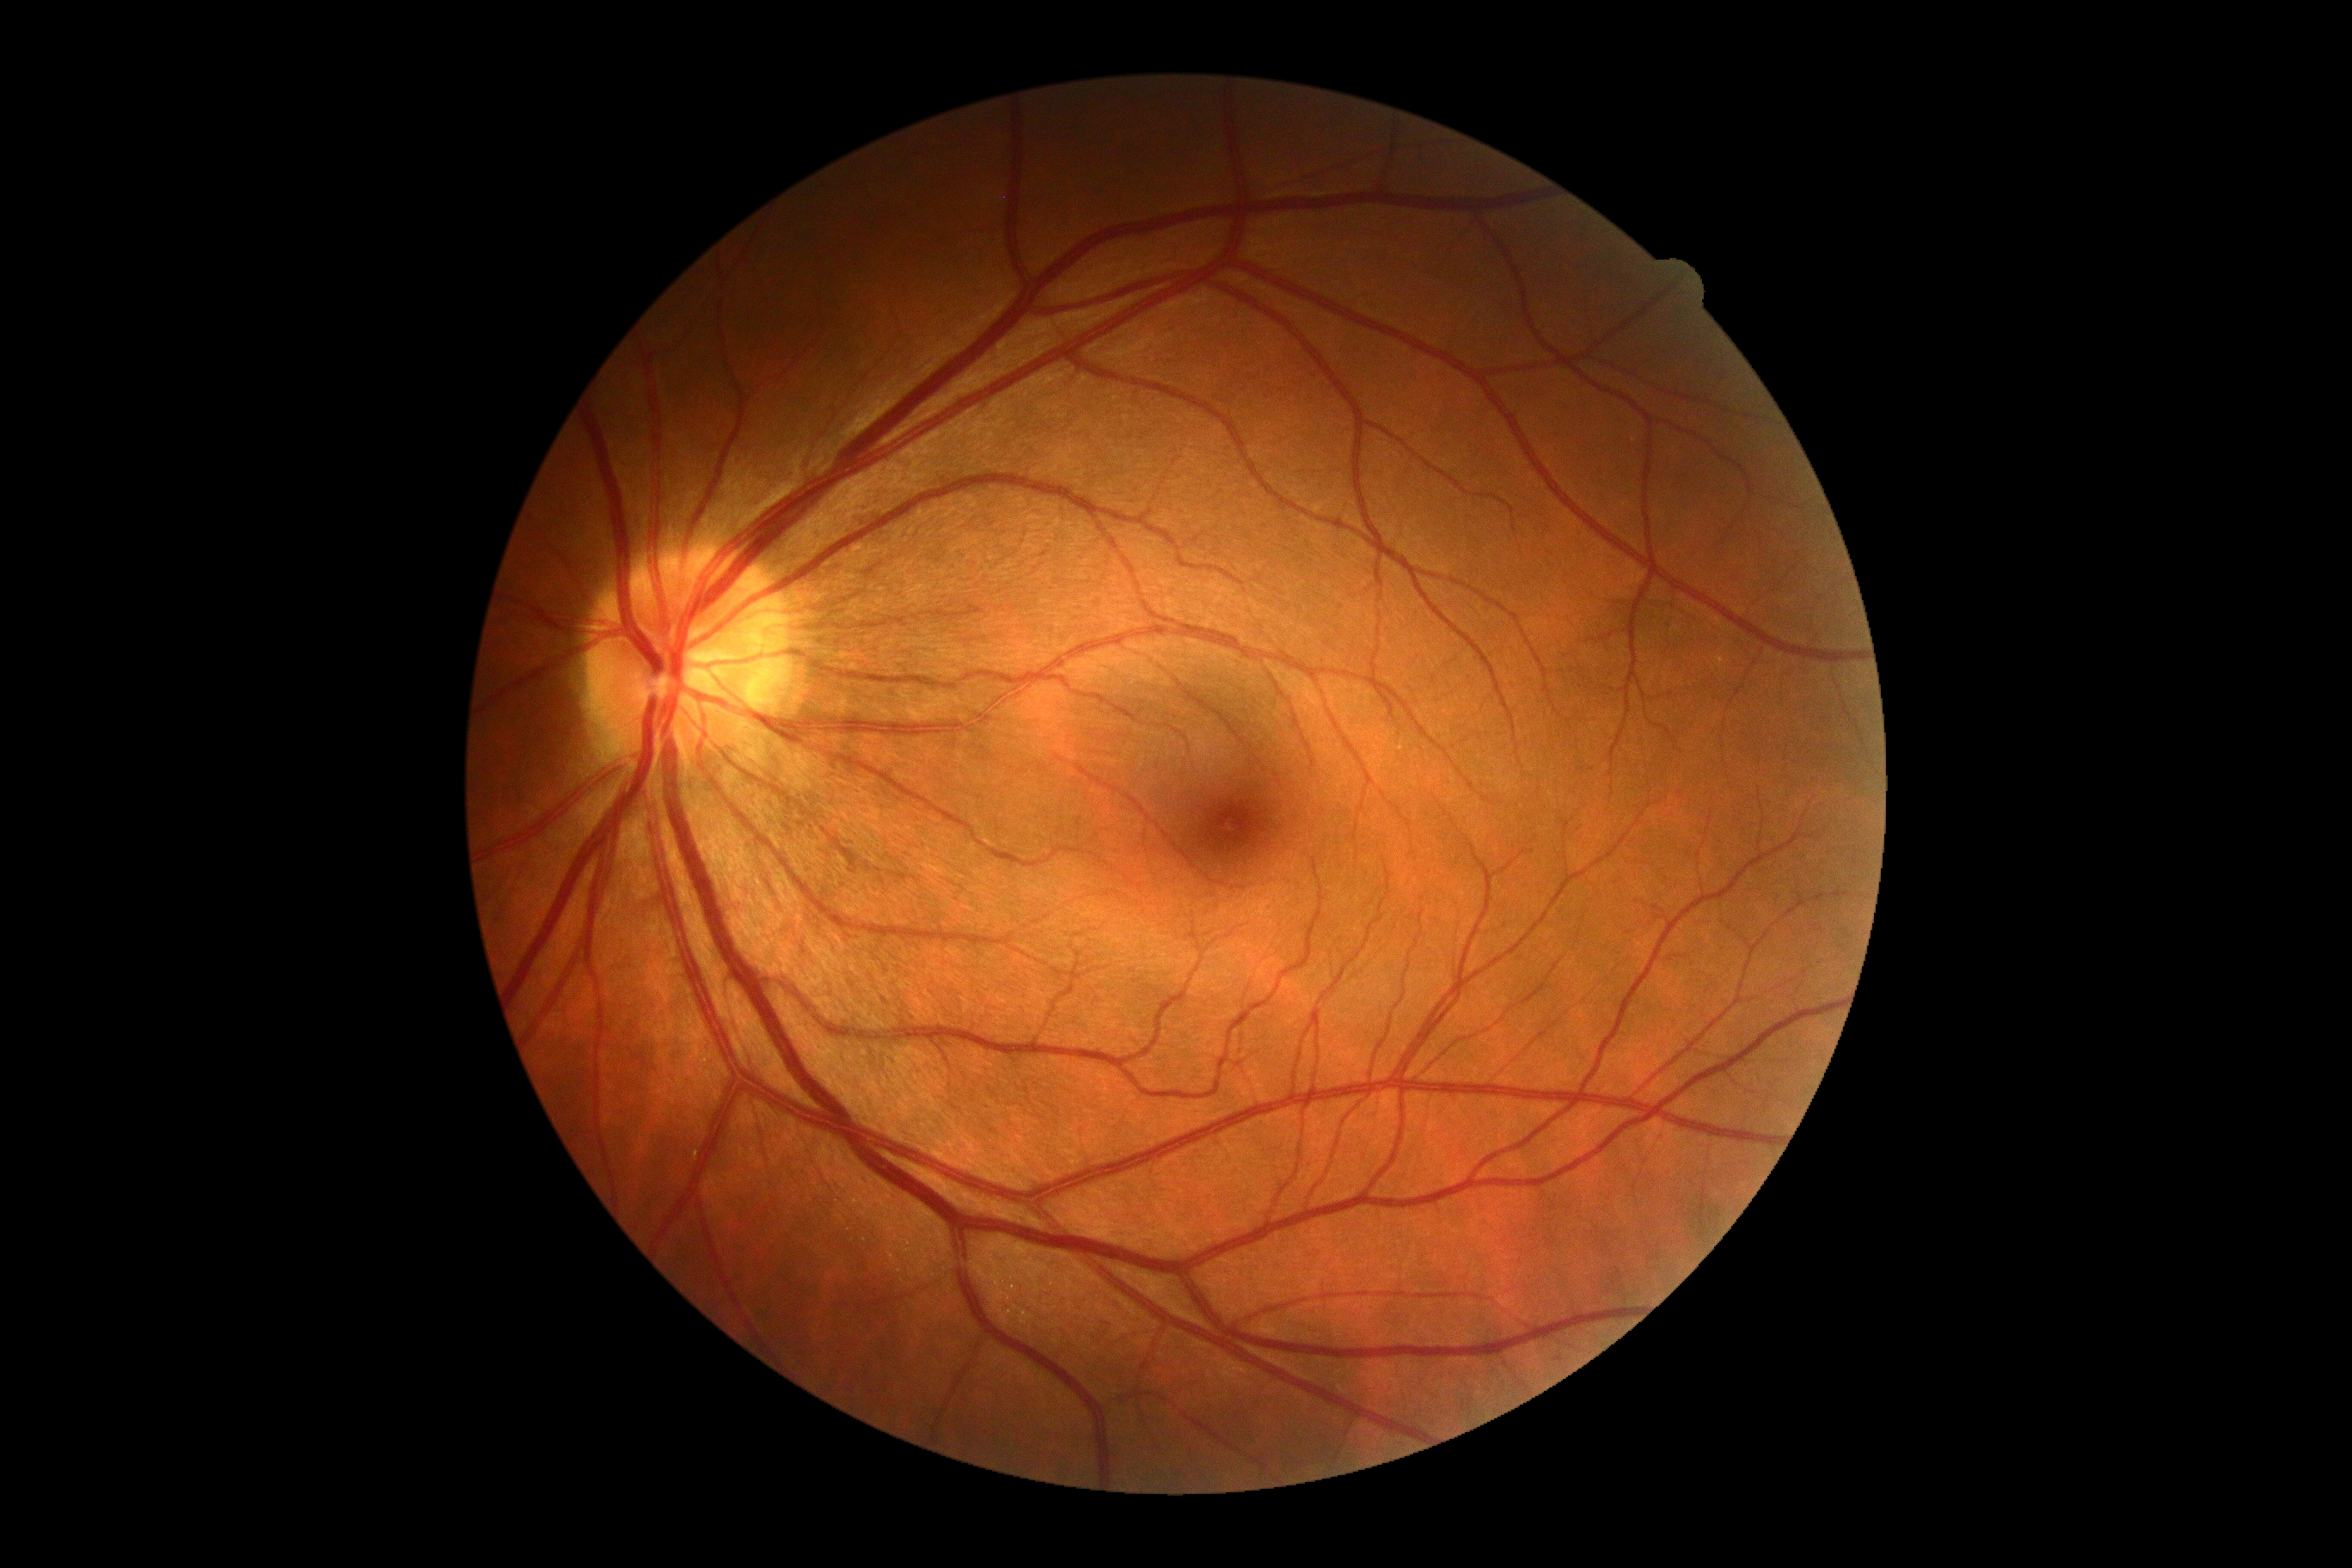
diabetic retinopathy grade: 0.